1924x1556 · wide-field retinal mosaic image.
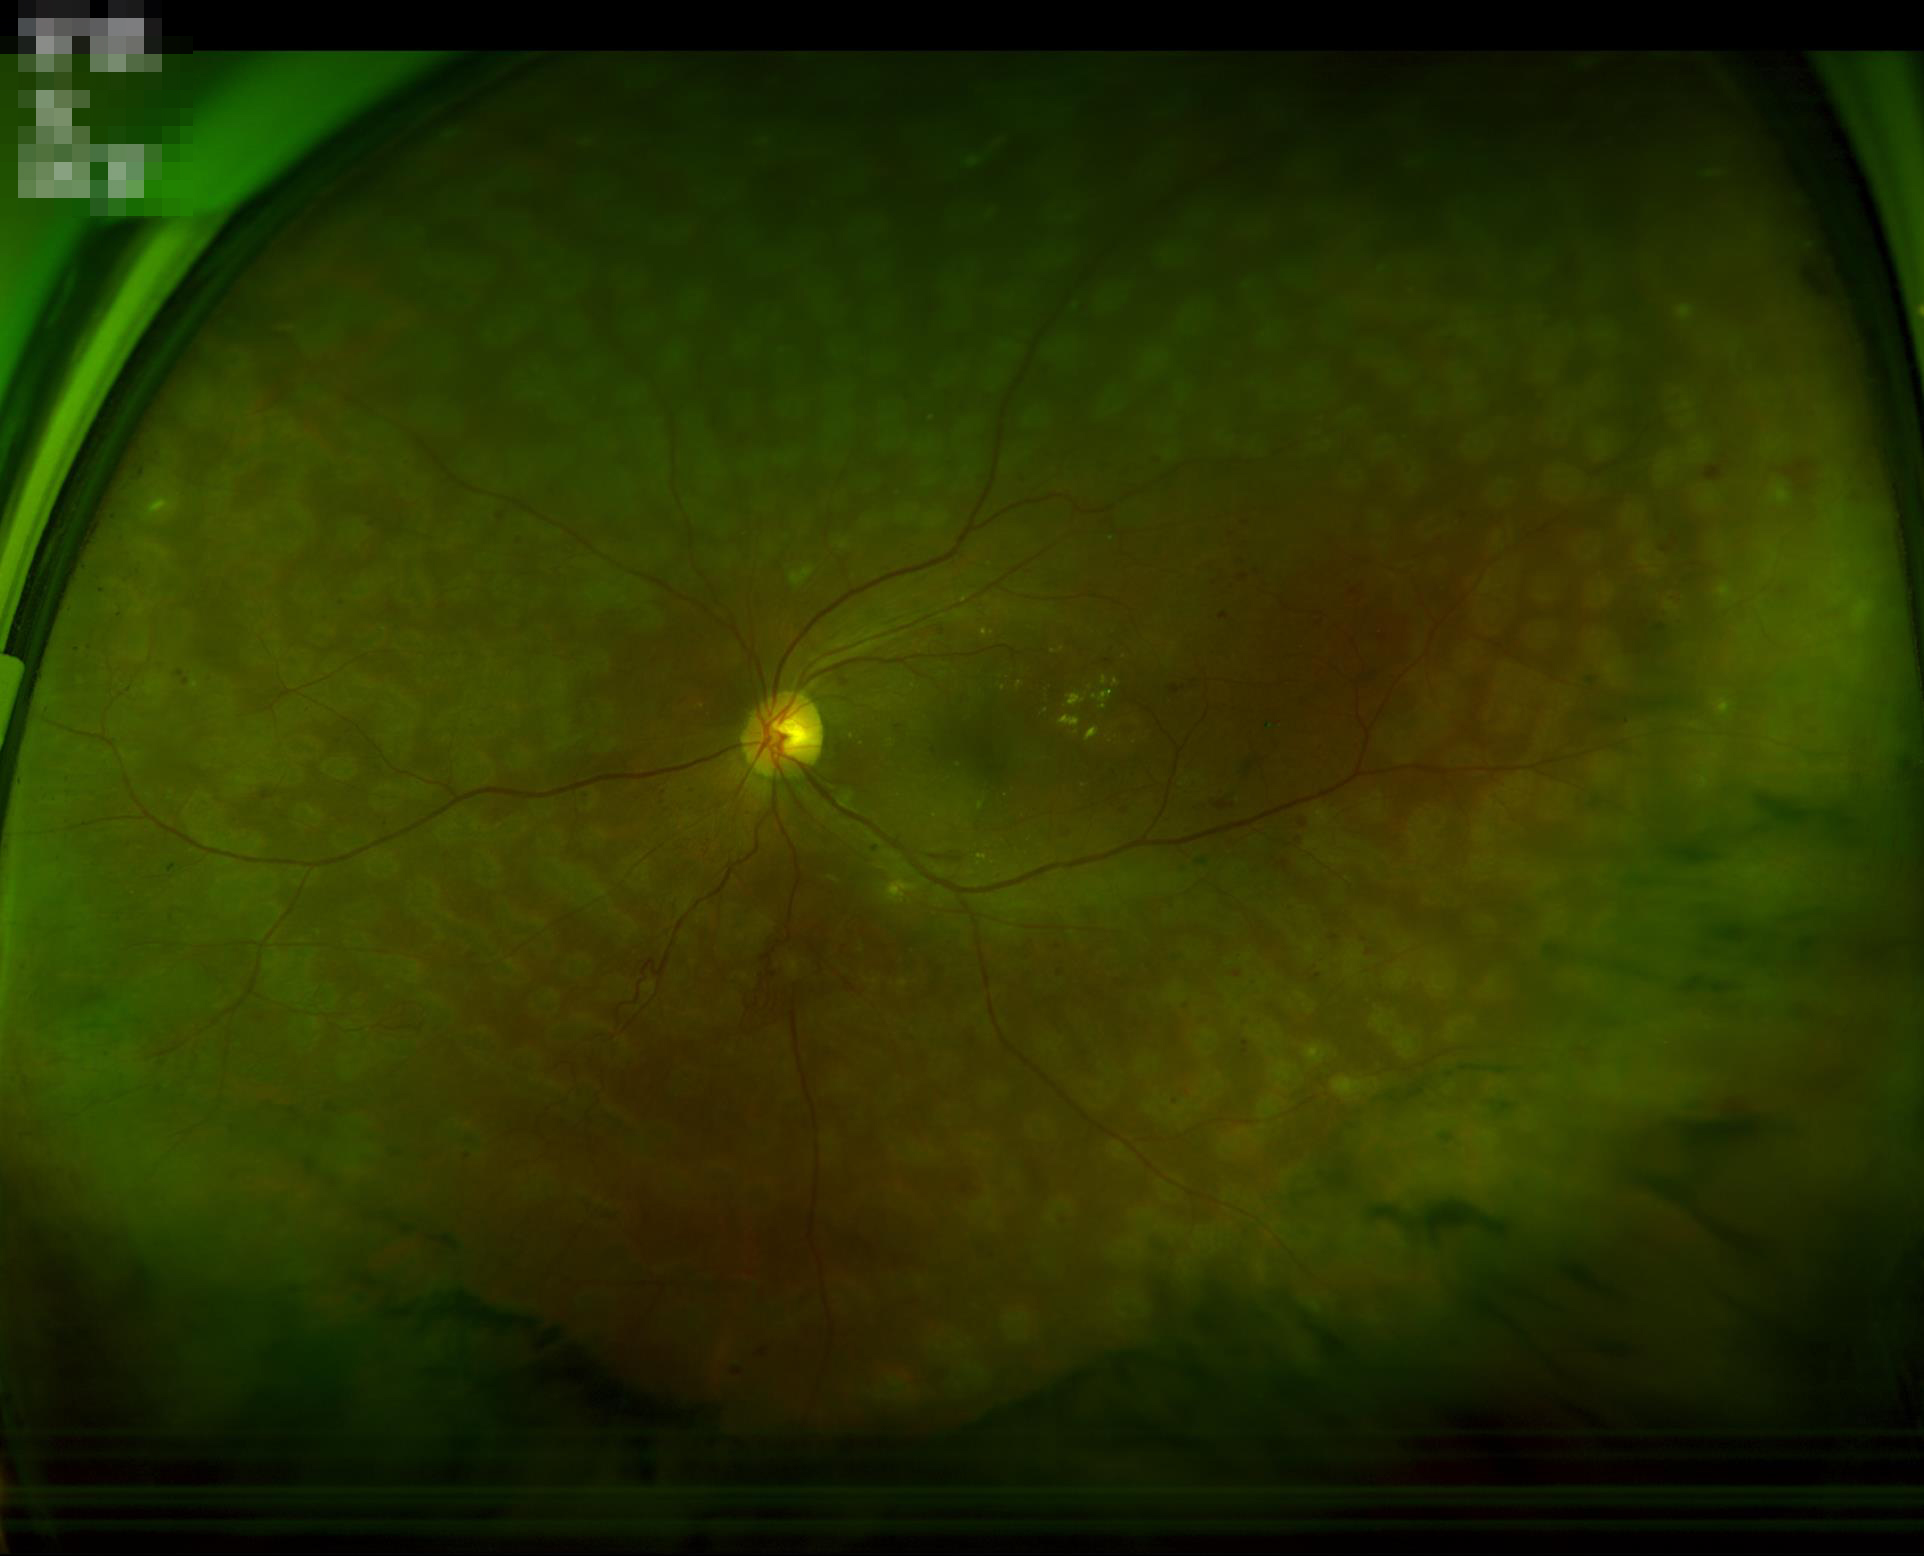
Illumination is even. Overall quality is good and the image is gradable. Adequate contrast for distinguishing structures. Image is sharp throughout the field.